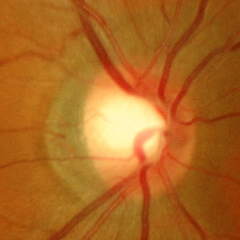

The image shows no evidence of glaucoma.